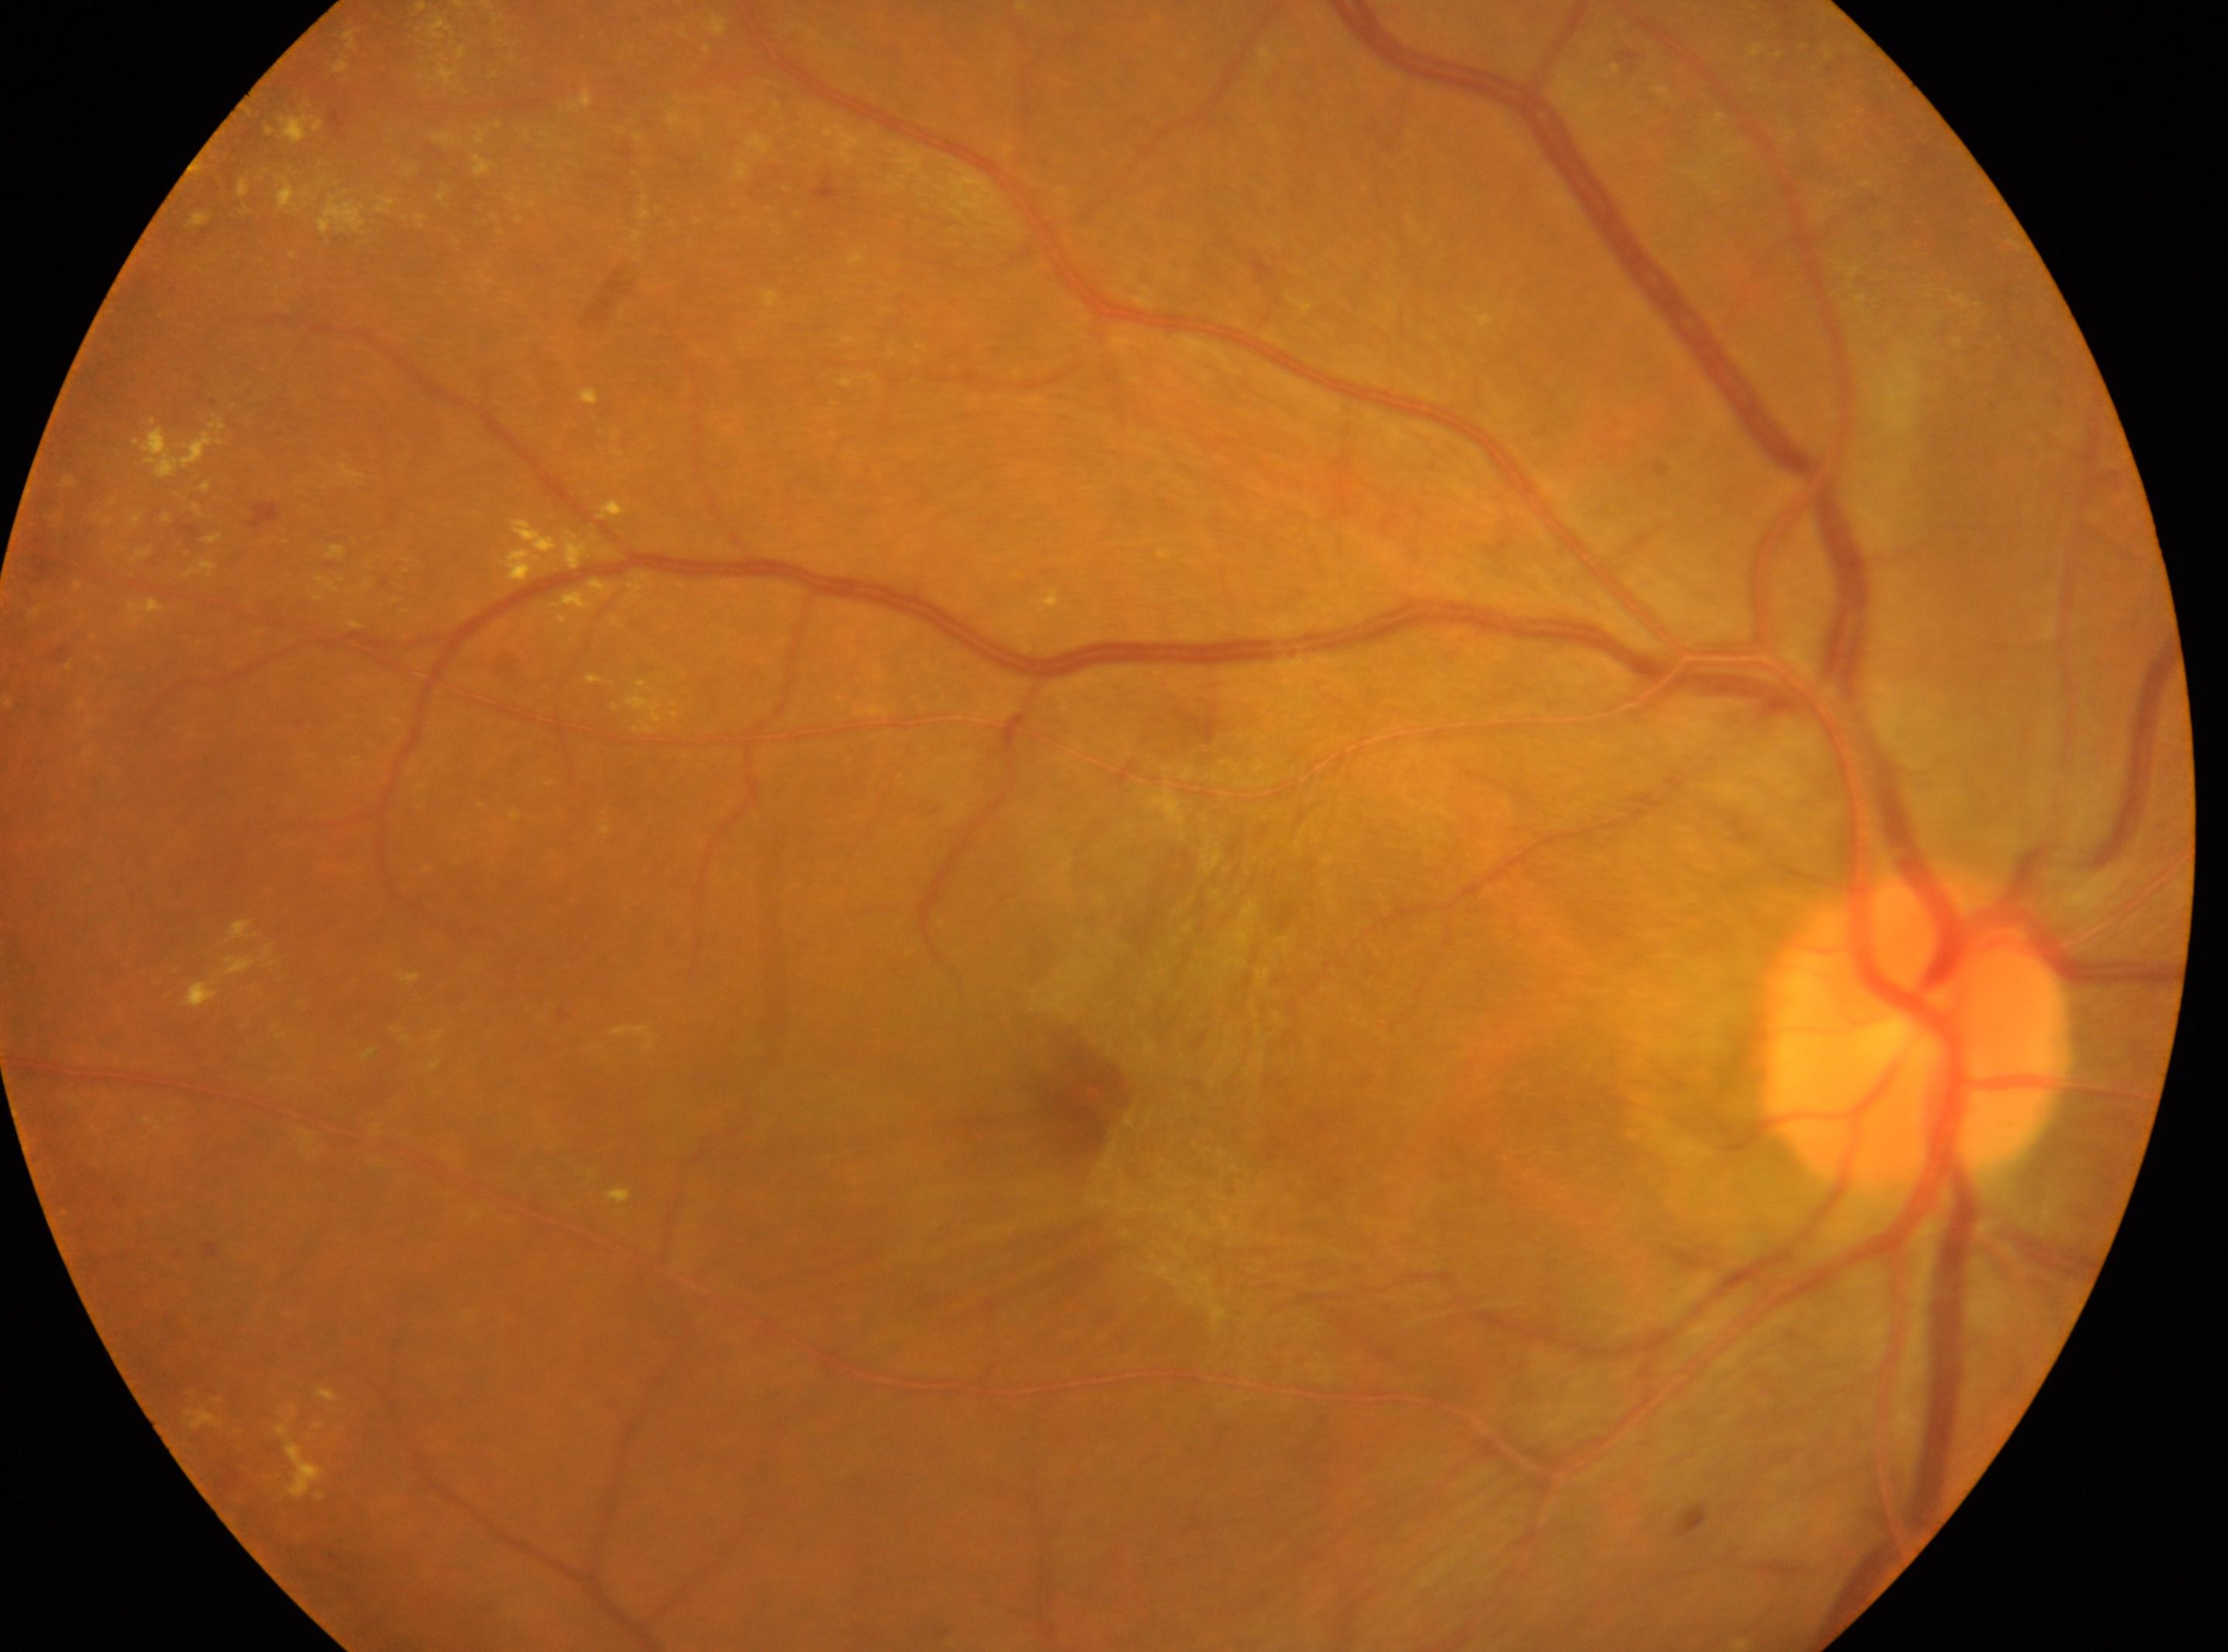

optic disc center: 1915, 1033; retinopathy grade: 4 (PDR); foveal center: 1080, 1097; the right eye.